848x848px. Without pupil dilation. NIDEK AFC-230. Color fundus image — 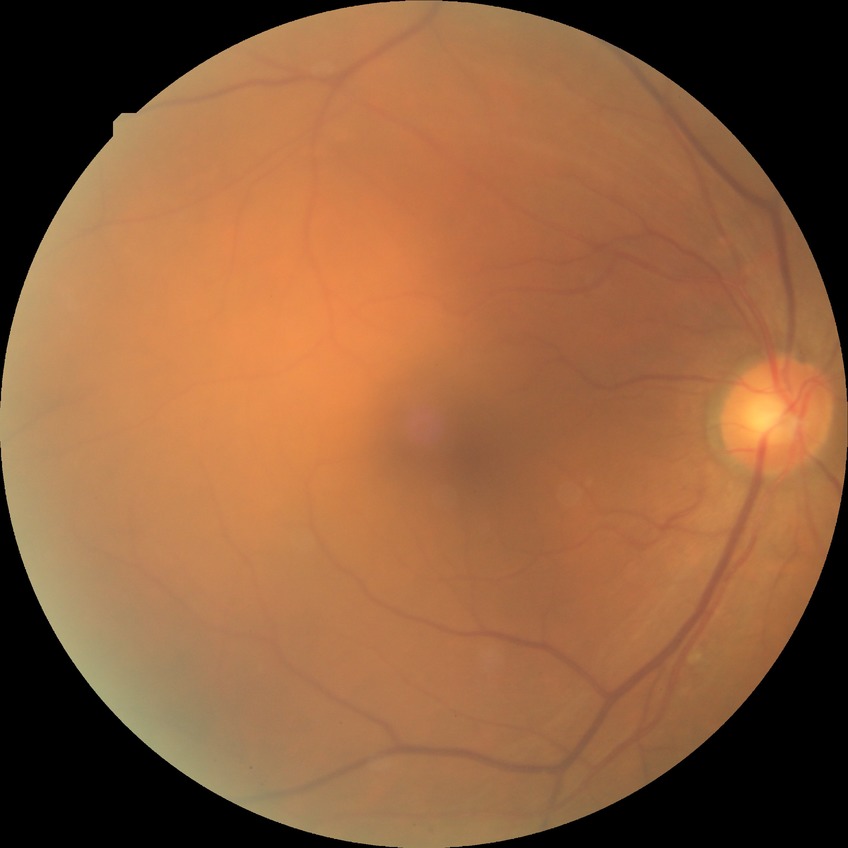 DR severity: SDR.